1932 by 1932 pixels: 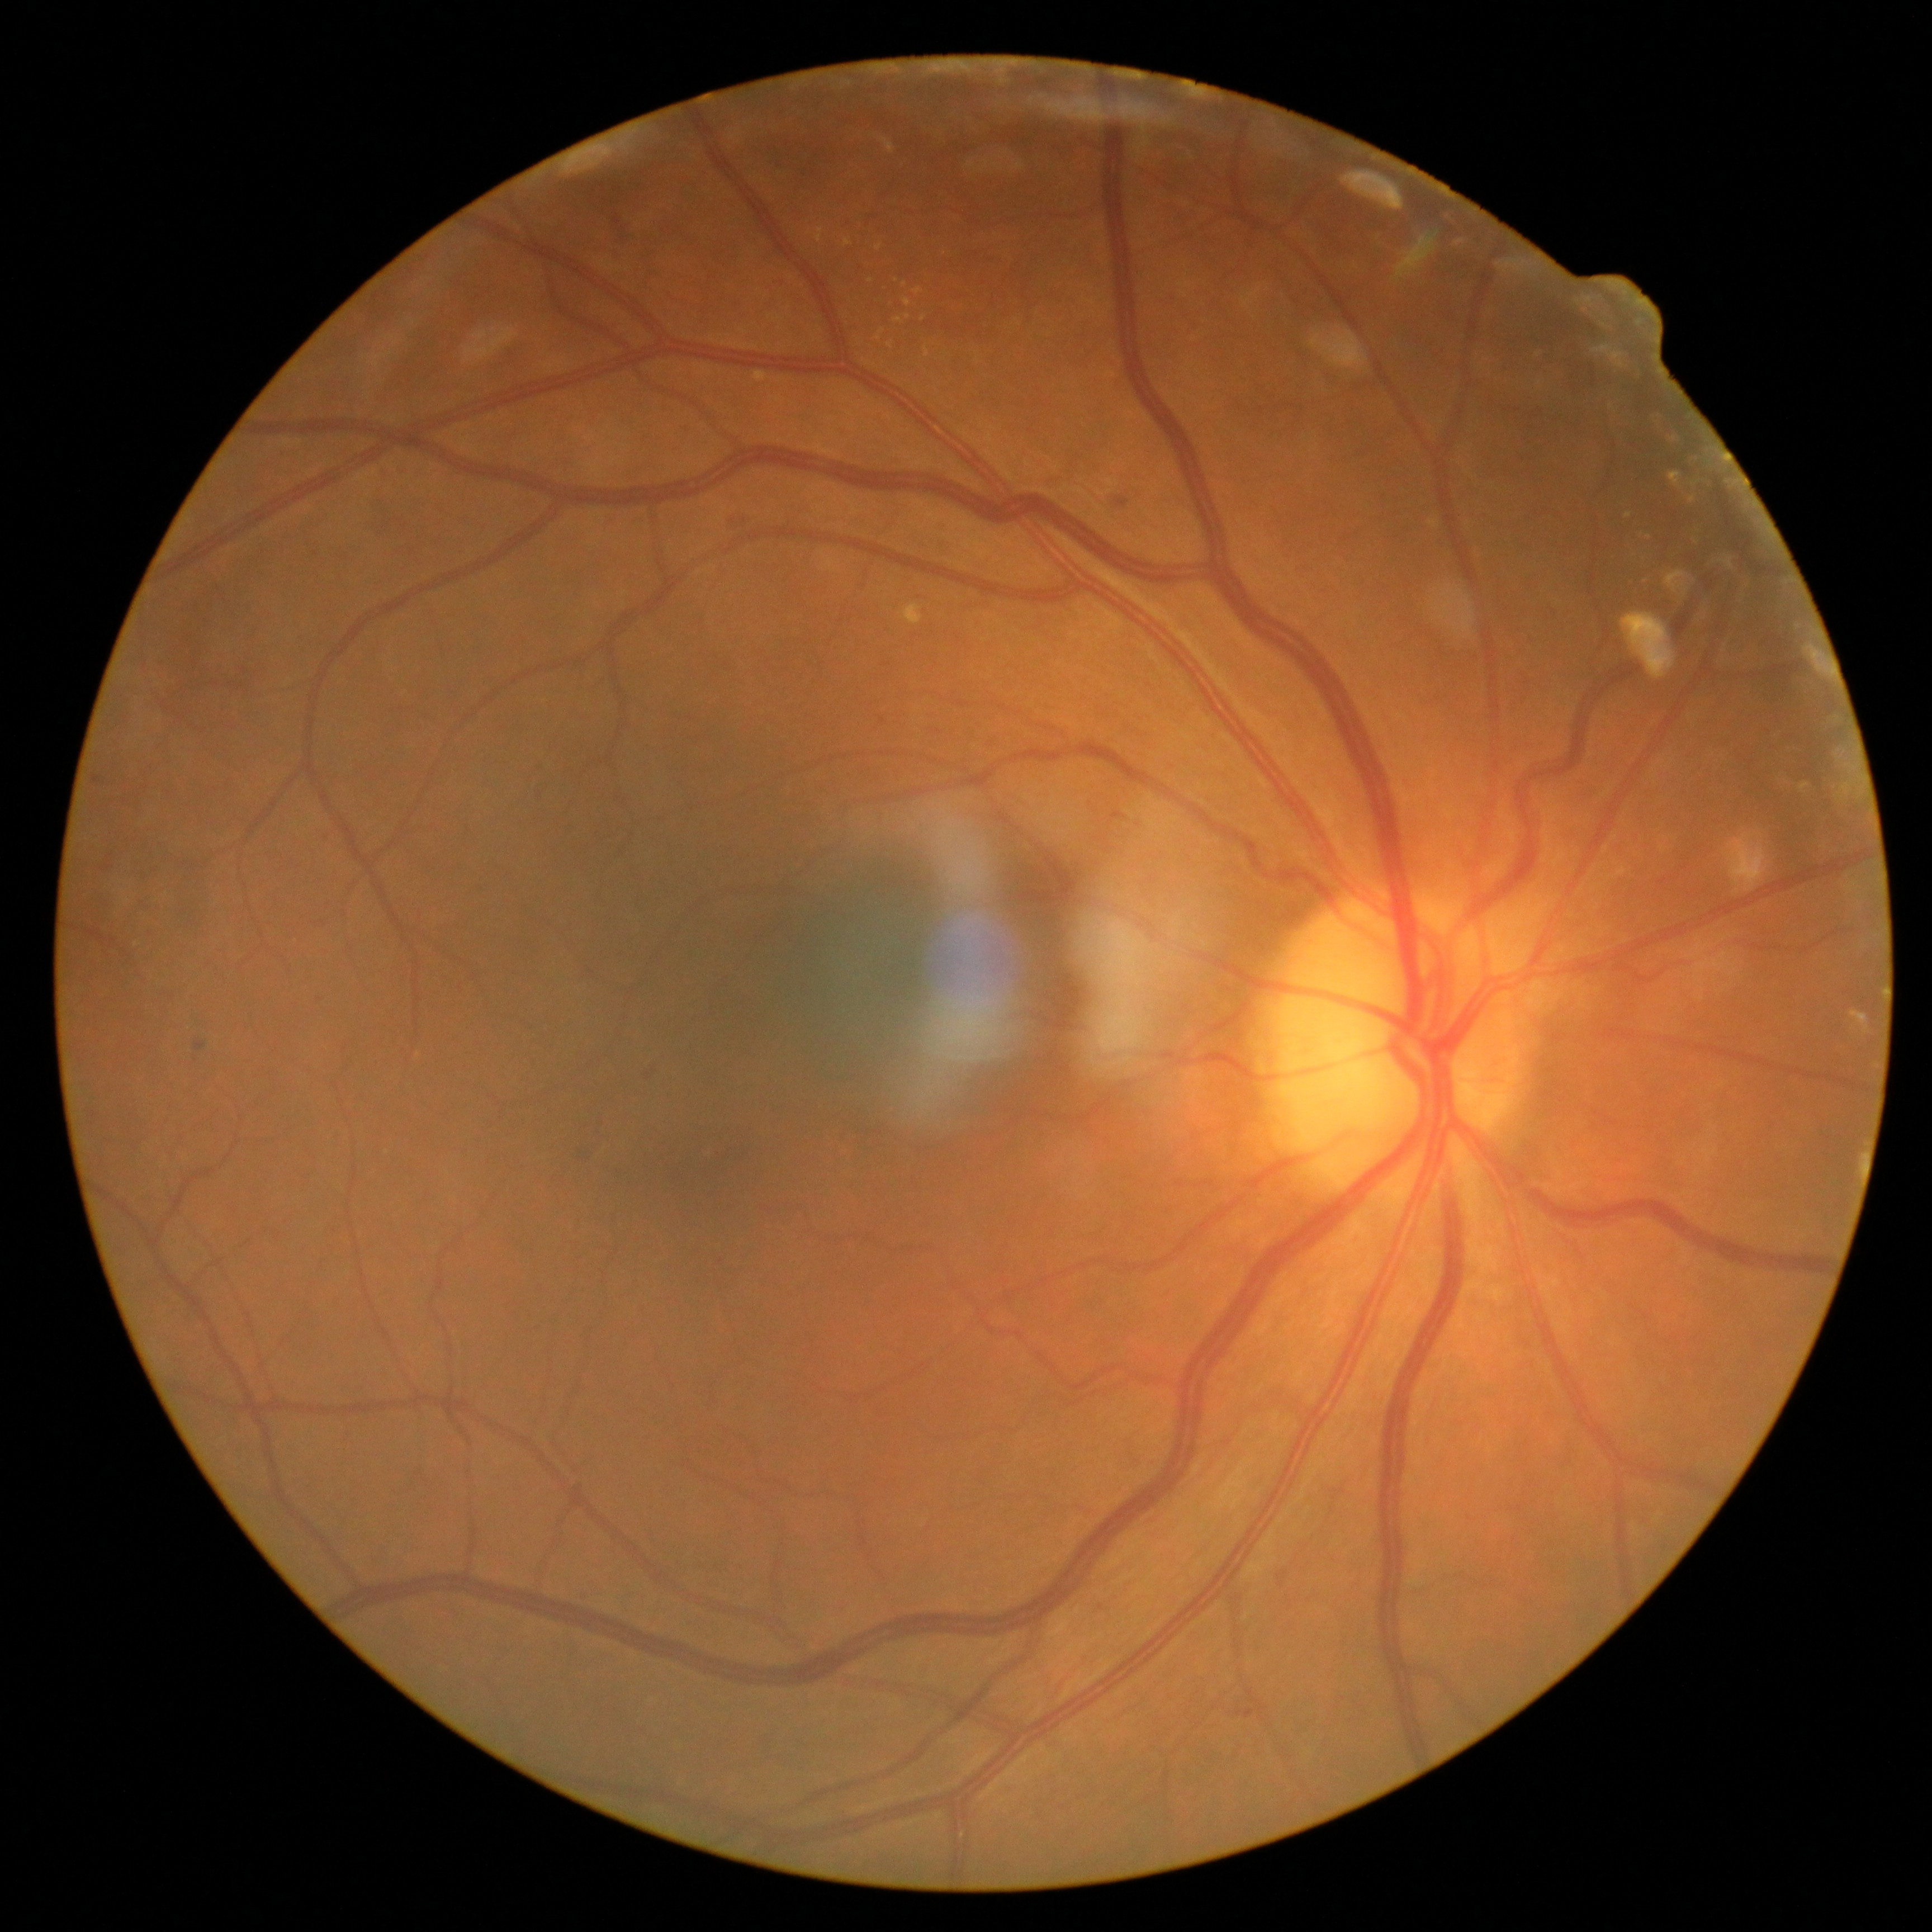
Diabetic retinopathy (DR) is 2 — more than just microaneurysms but less than severe NPDR.